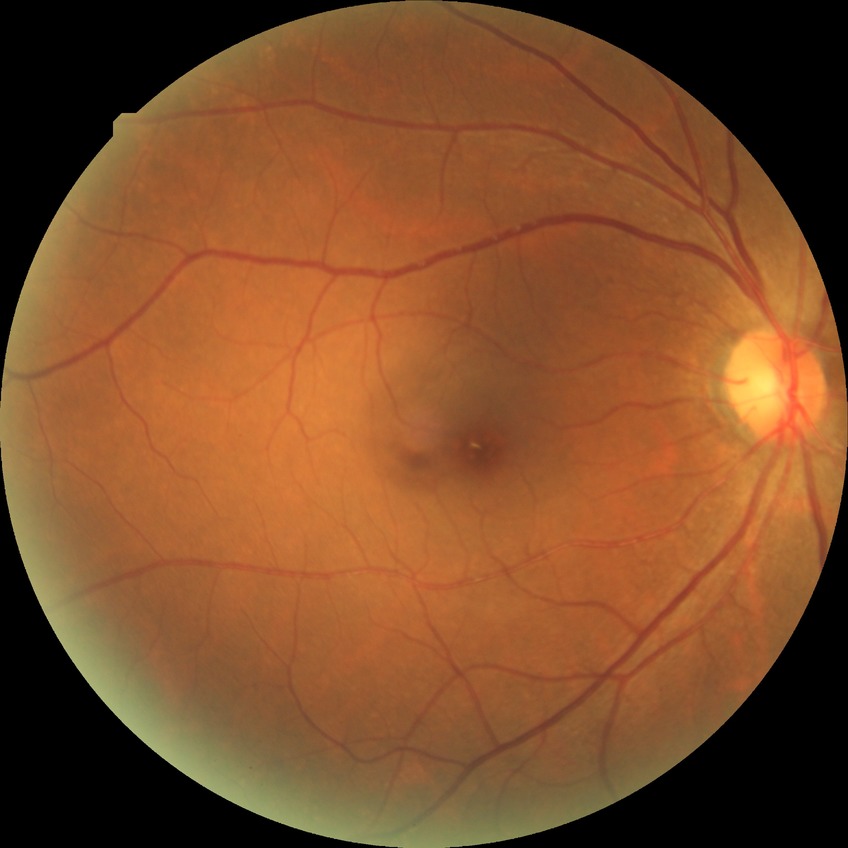

Modified Davis classification: no diabetic retinopathy.